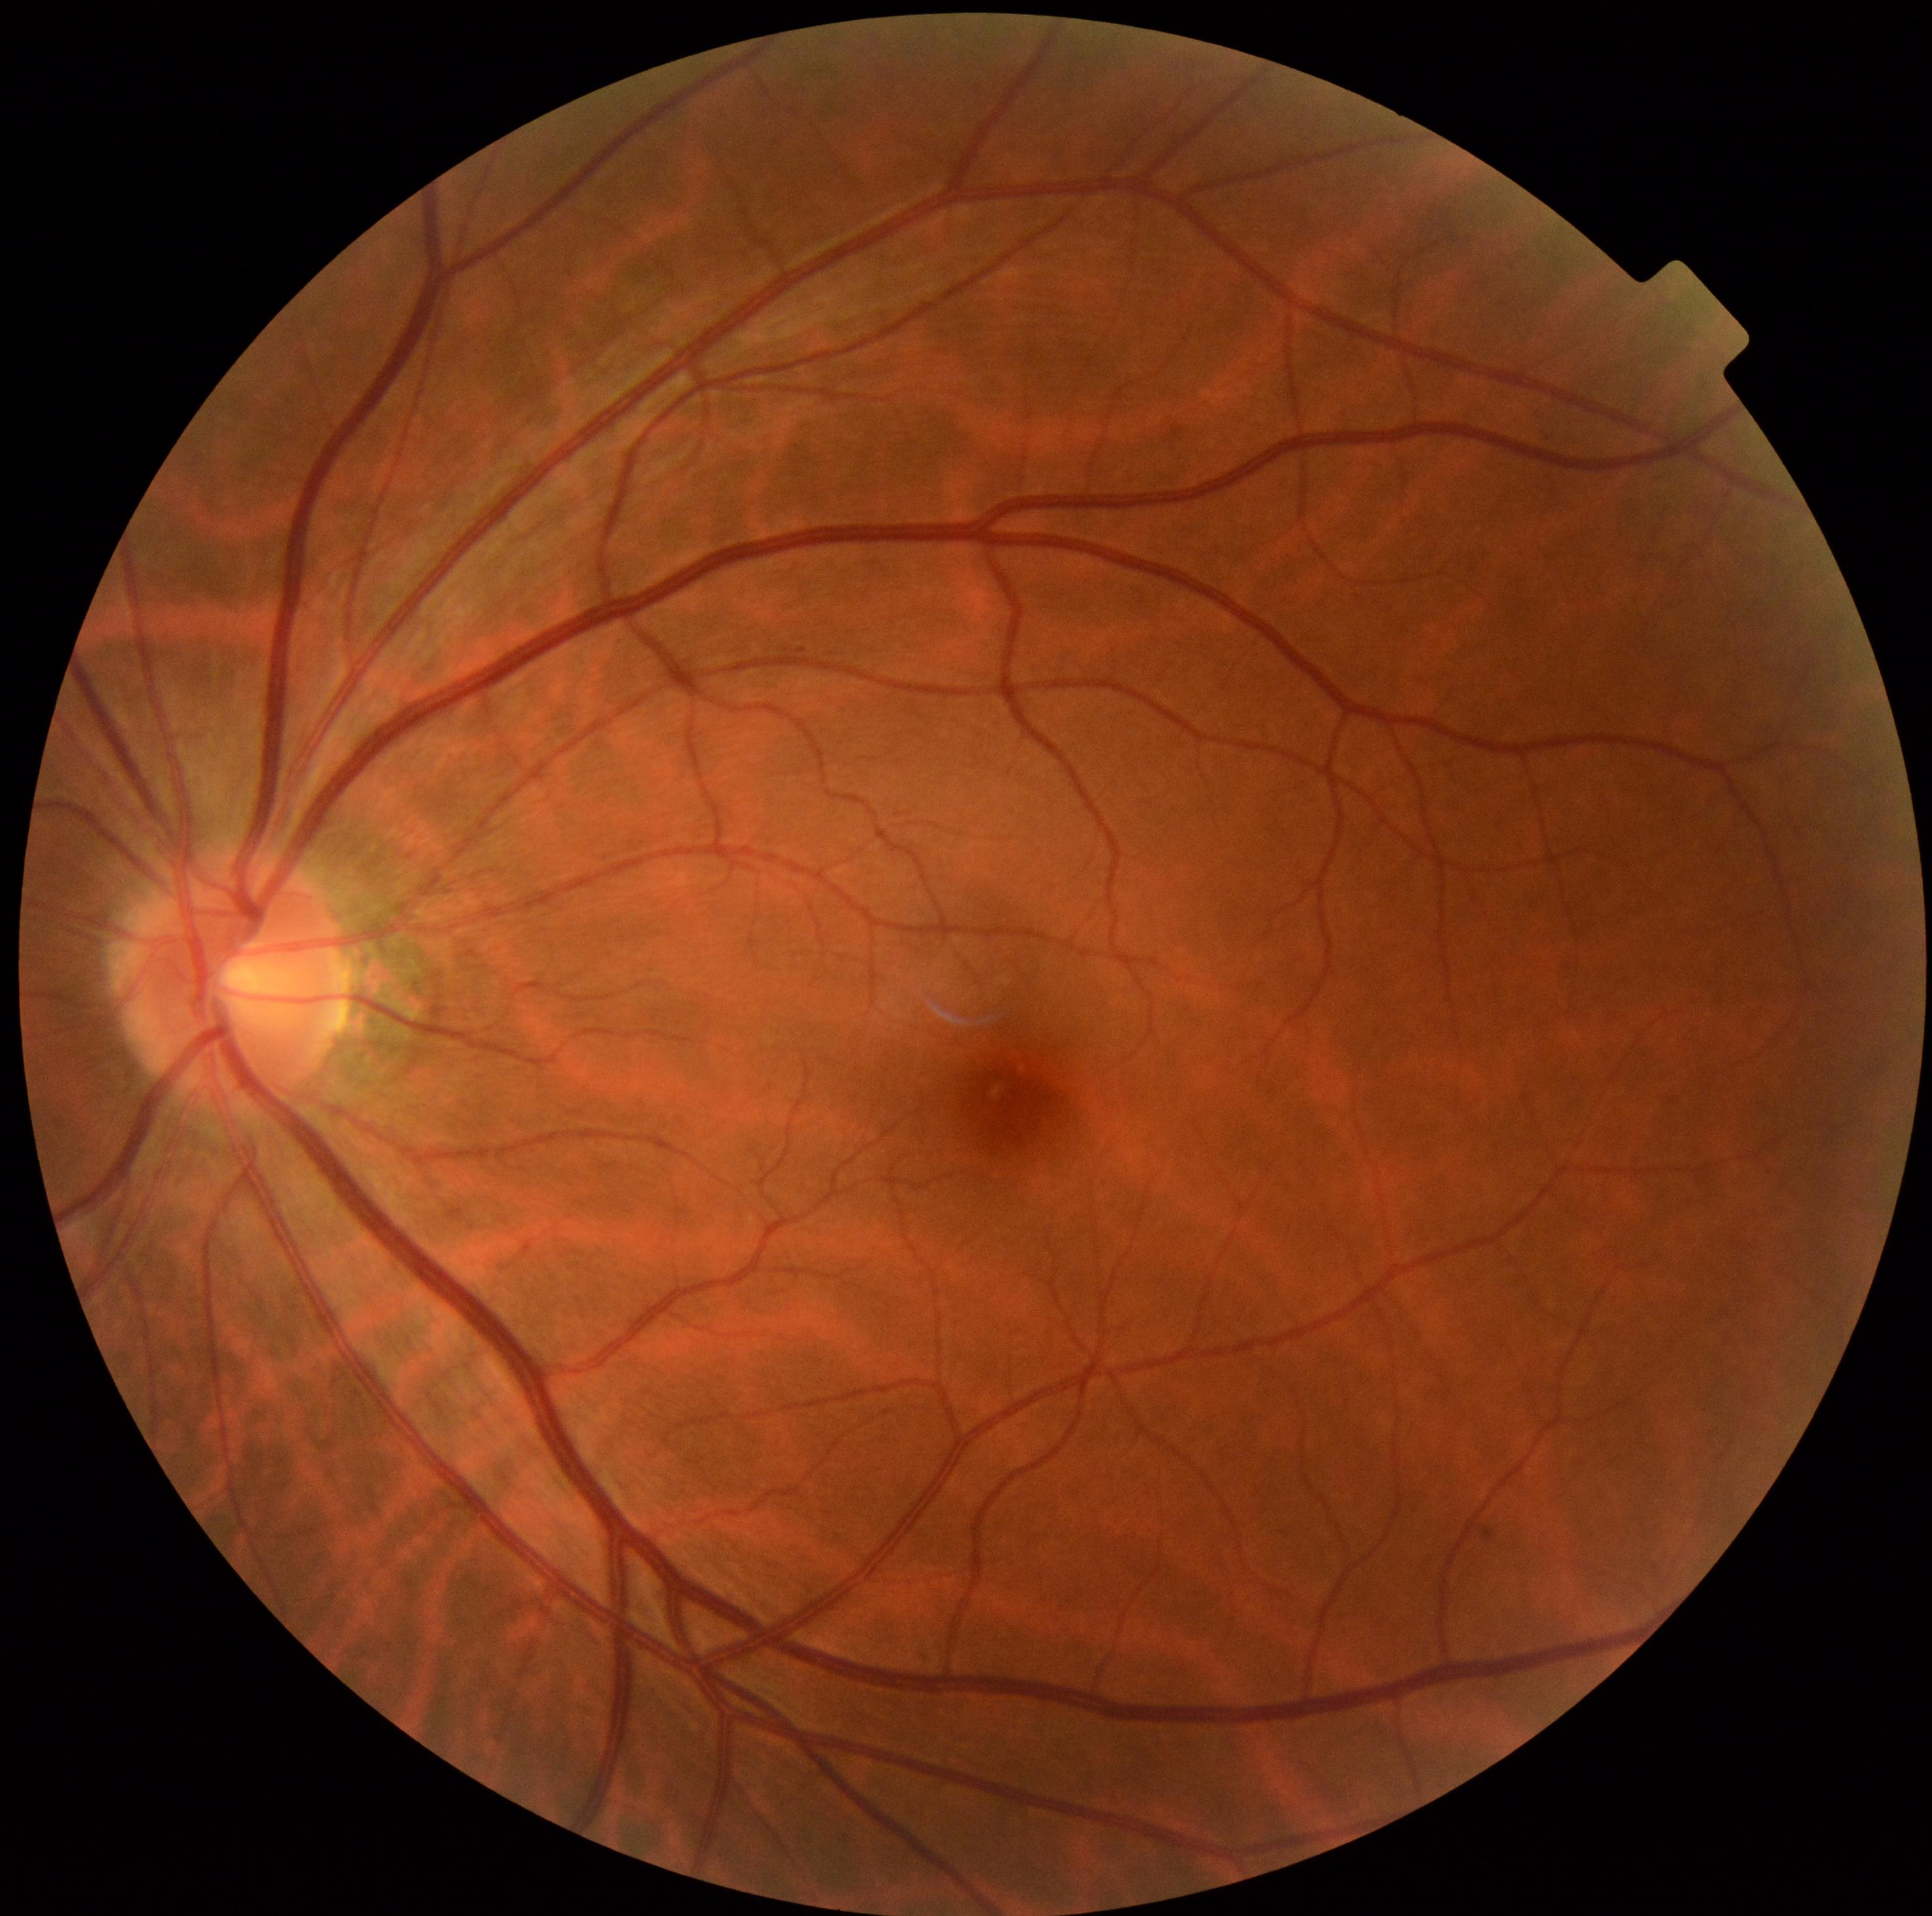

Retinopathy: grade 0.